45-degree field of view, NIDEK AFC-230 fundus camera, nonmydriatic: 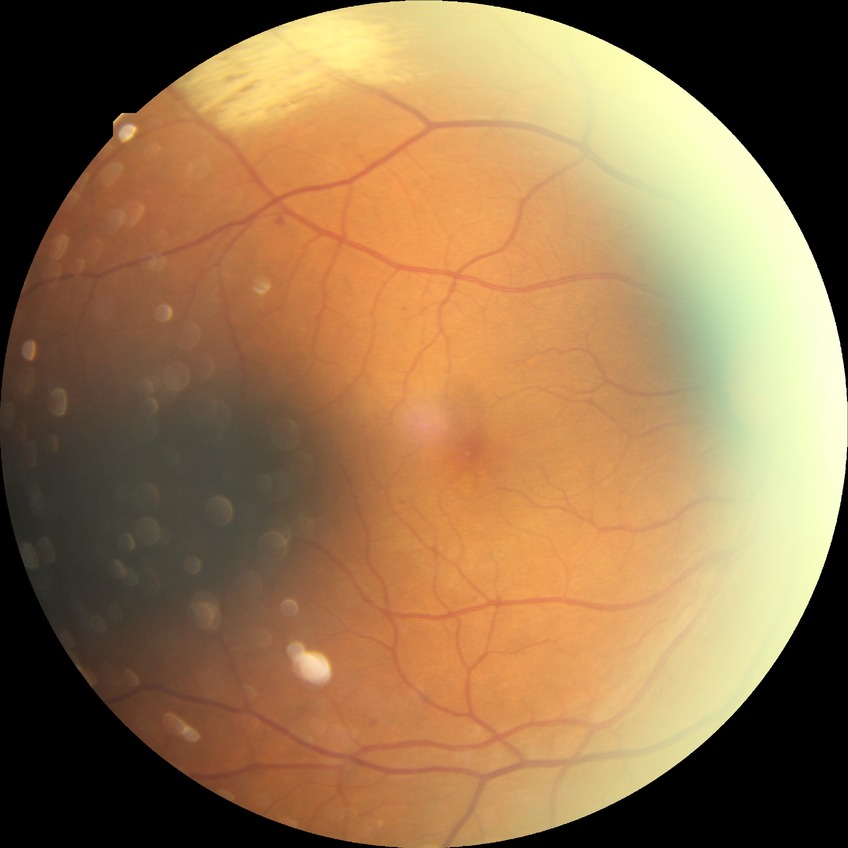
Diabetic retinopathy (DR): SDR (simple diabetic retinopathy).